Image size 848x848 · acquired with a NIDEK AFC-230:
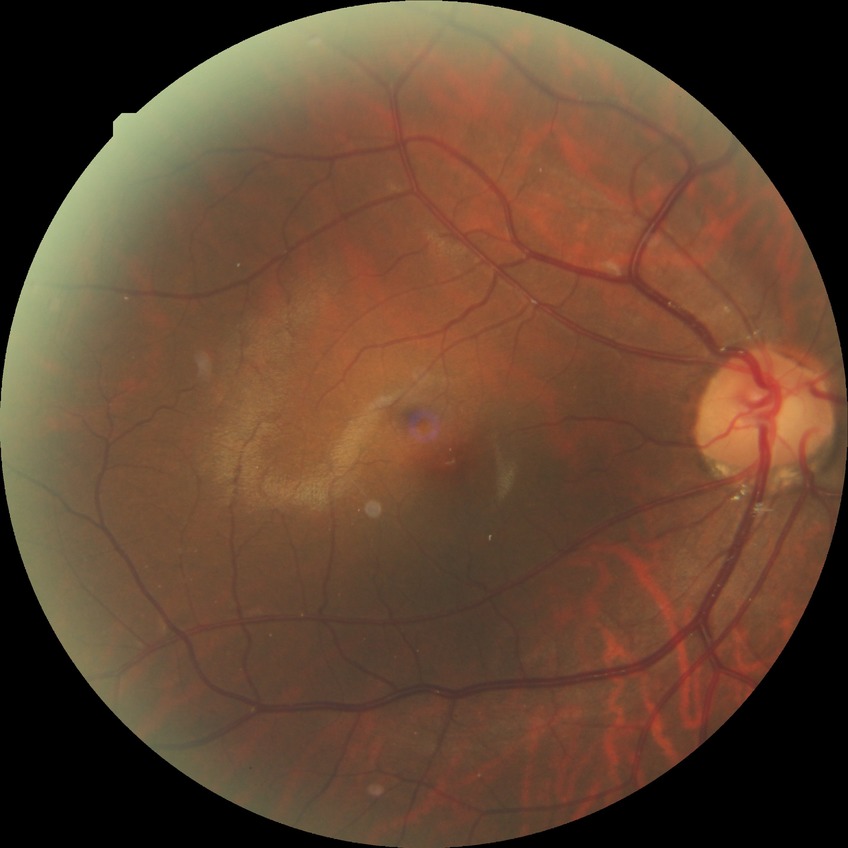

No DR findings. Davis stage: NDR.